Color fundus image; 2228 by 1652 pixels; captured on a Topcon TRC-50DX fundus camera; dilated-pupil acquisition; posterior pole field covering the optic disc and macula: 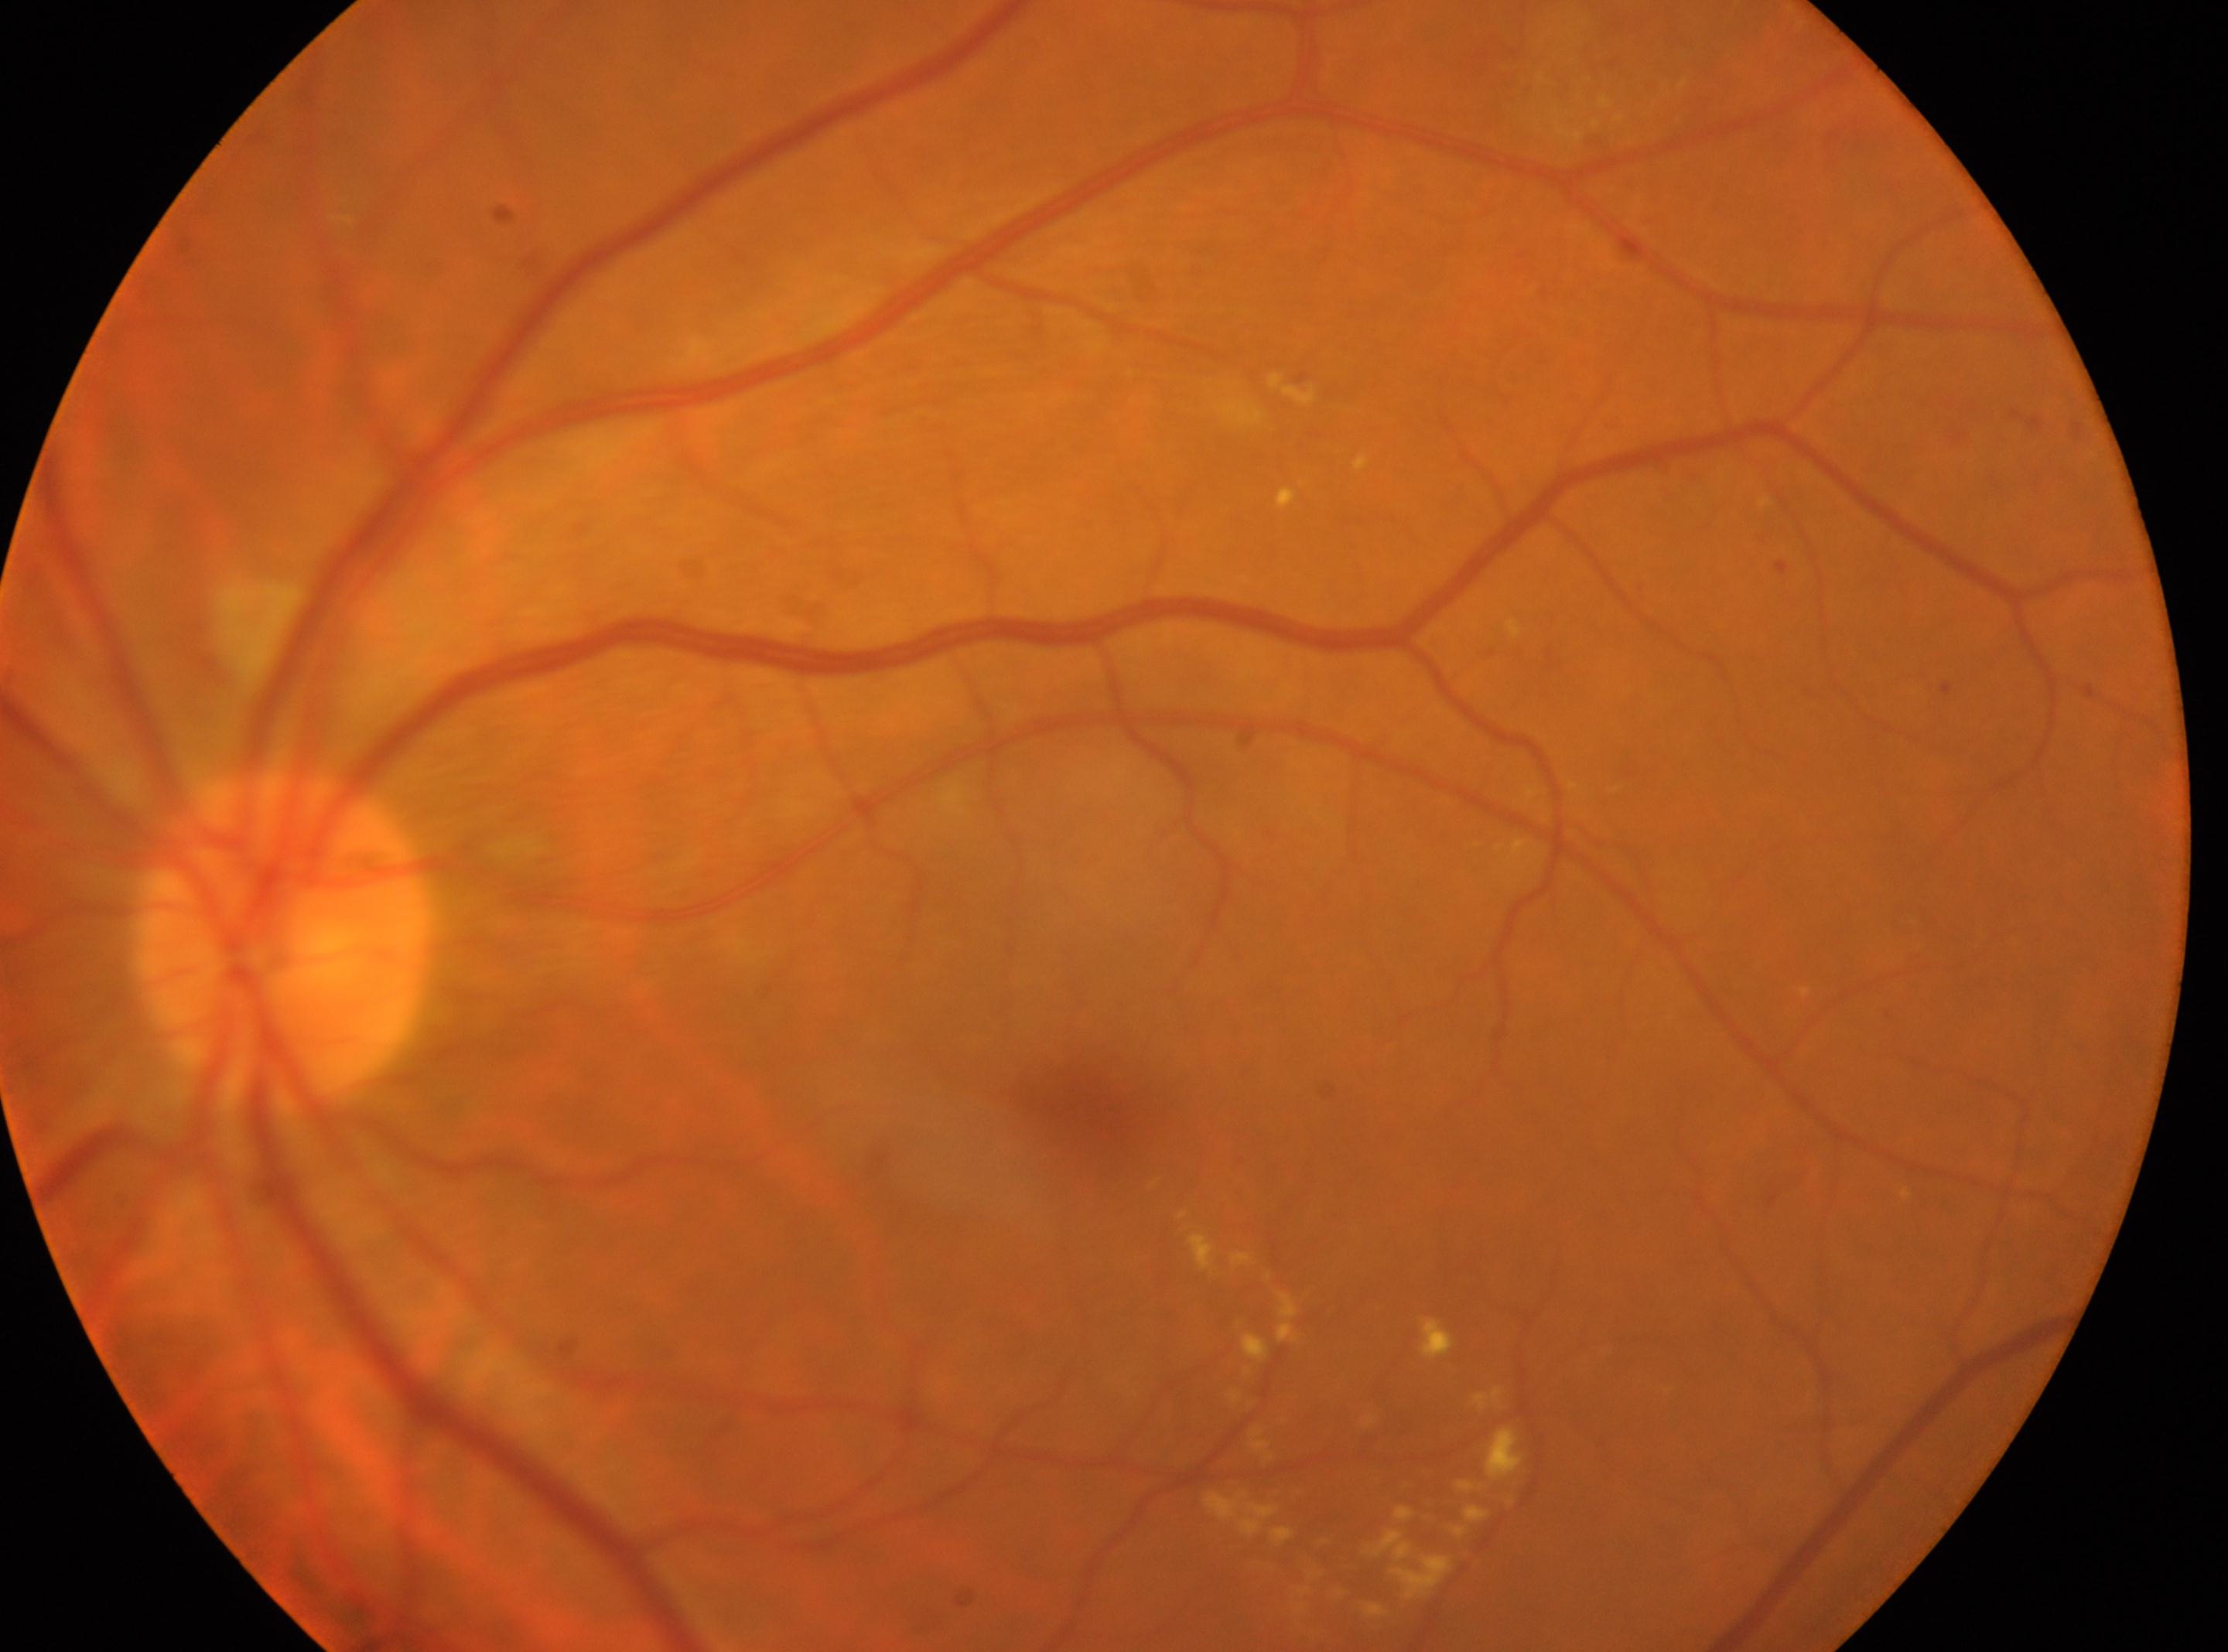 Retinopathy grade: 2/4. The optic disc center is at [283, 939]. DR class: non-proliferative diabetic retinopathy. Macula center located at [1085, 1109]. Imaged eye: left eye.